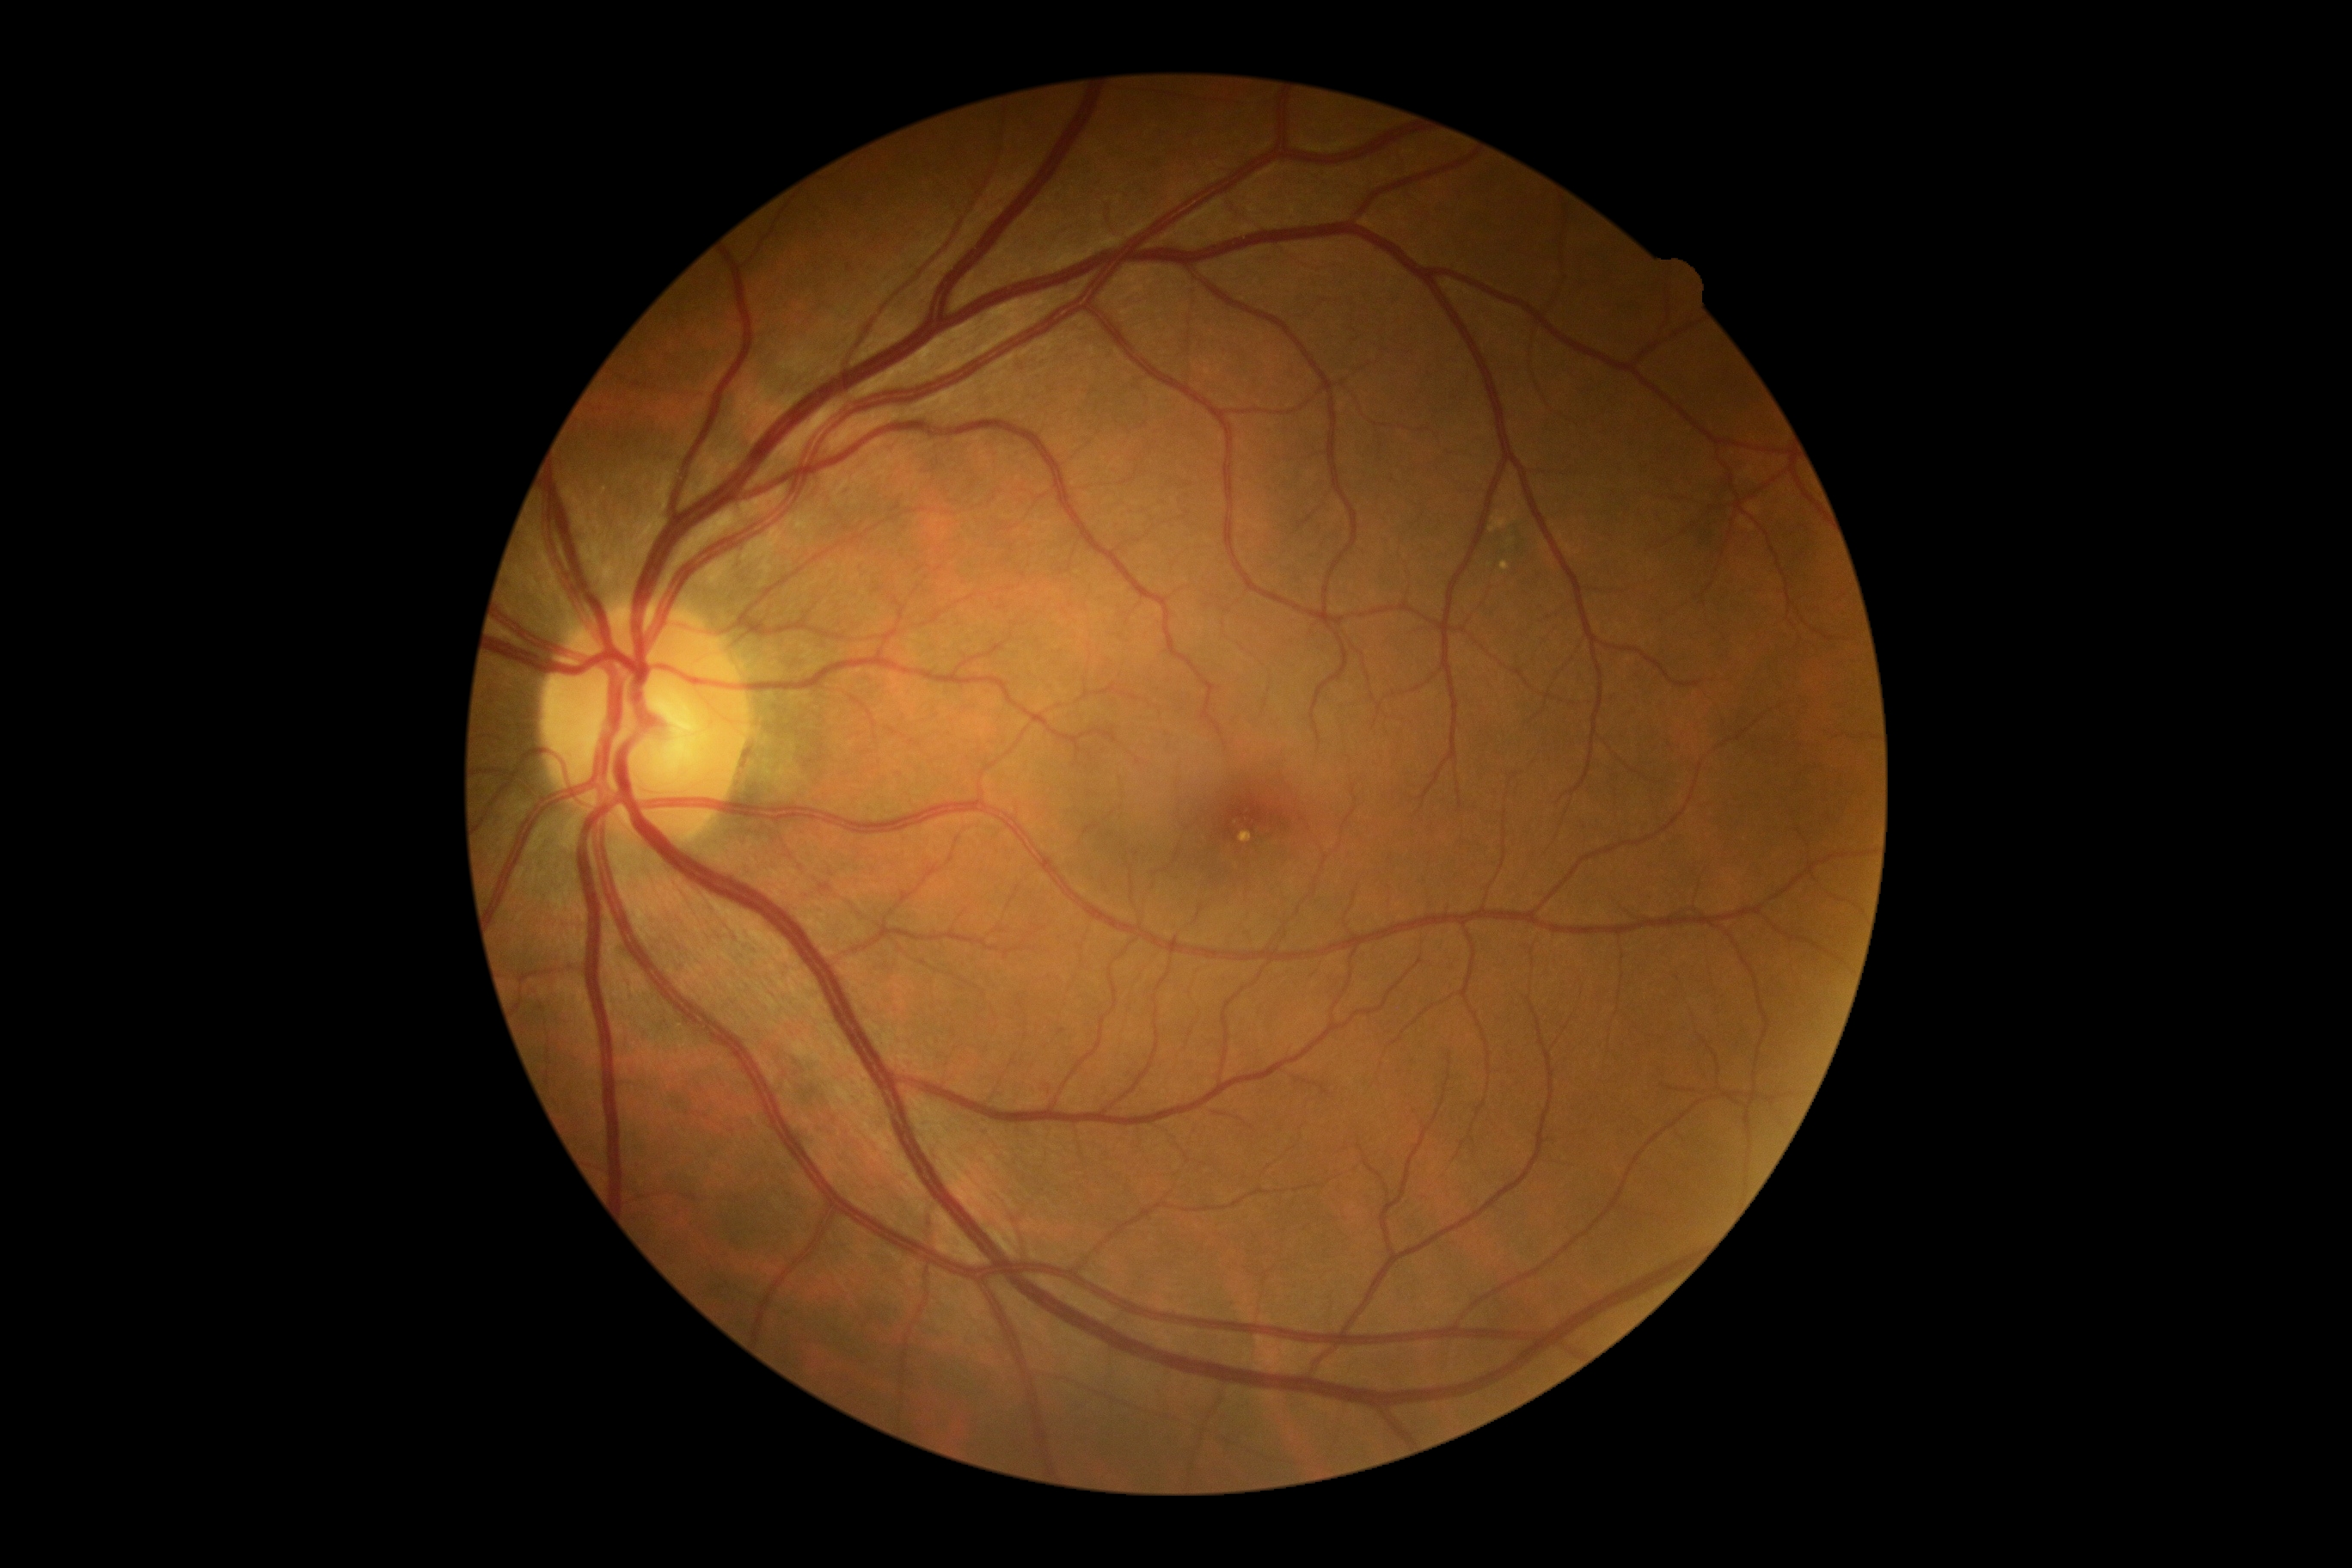

Findings:
* diabetic retinopathy (DR) — grade 0 (no apparent retinopathy)
* DR impression — no DR findings